Camera: NIDEK AFC-230, nonmydriatic, 45-degree field of view:
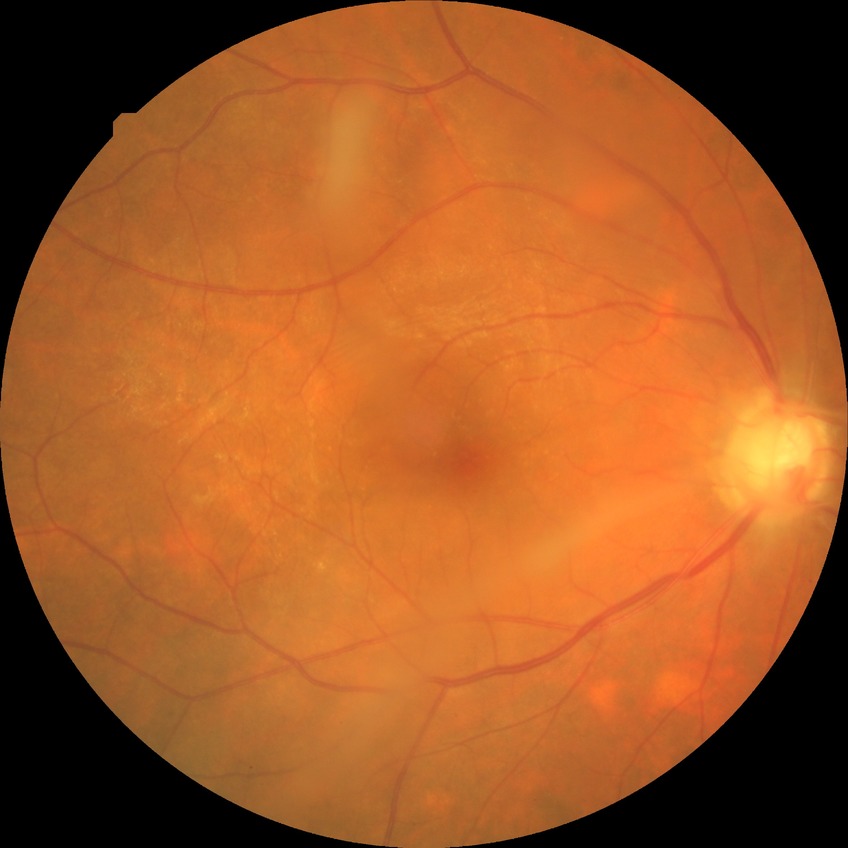 Findings:
• diabetic retinopathy (DR) — NDR (no diabetic retinopathy)